Graded on the modified Davis scale. 848 x 848 pixels. 45-degree field of view — 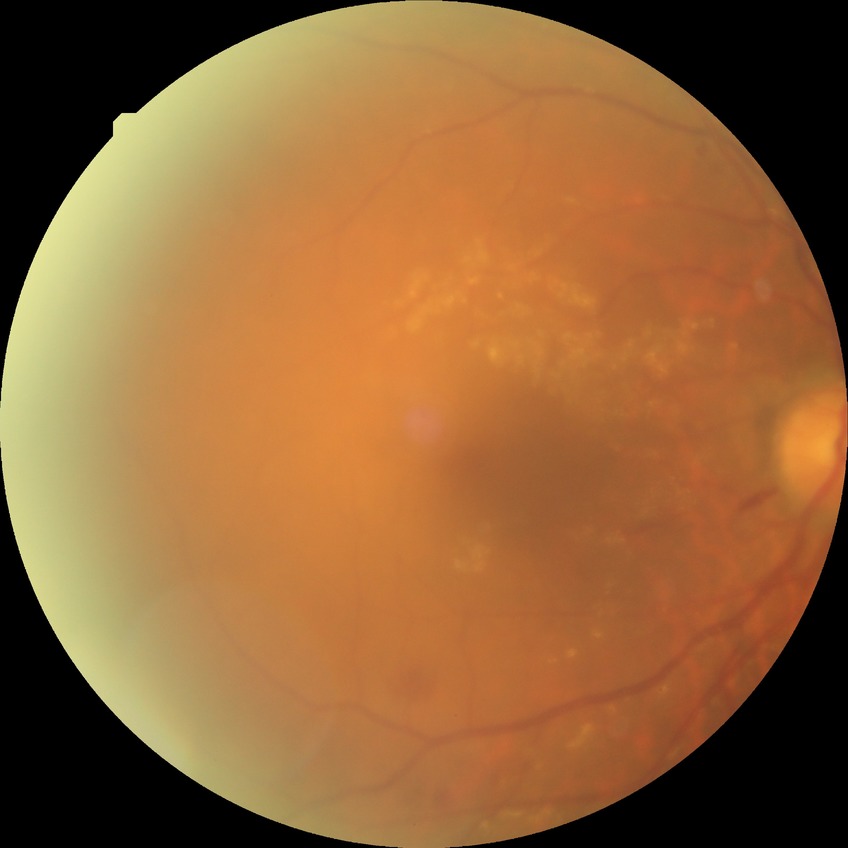 Findings:
– diabetic retinopathy (DR) — PPDR (pre-proliferative diabetic retinopathy)